2102x1736.
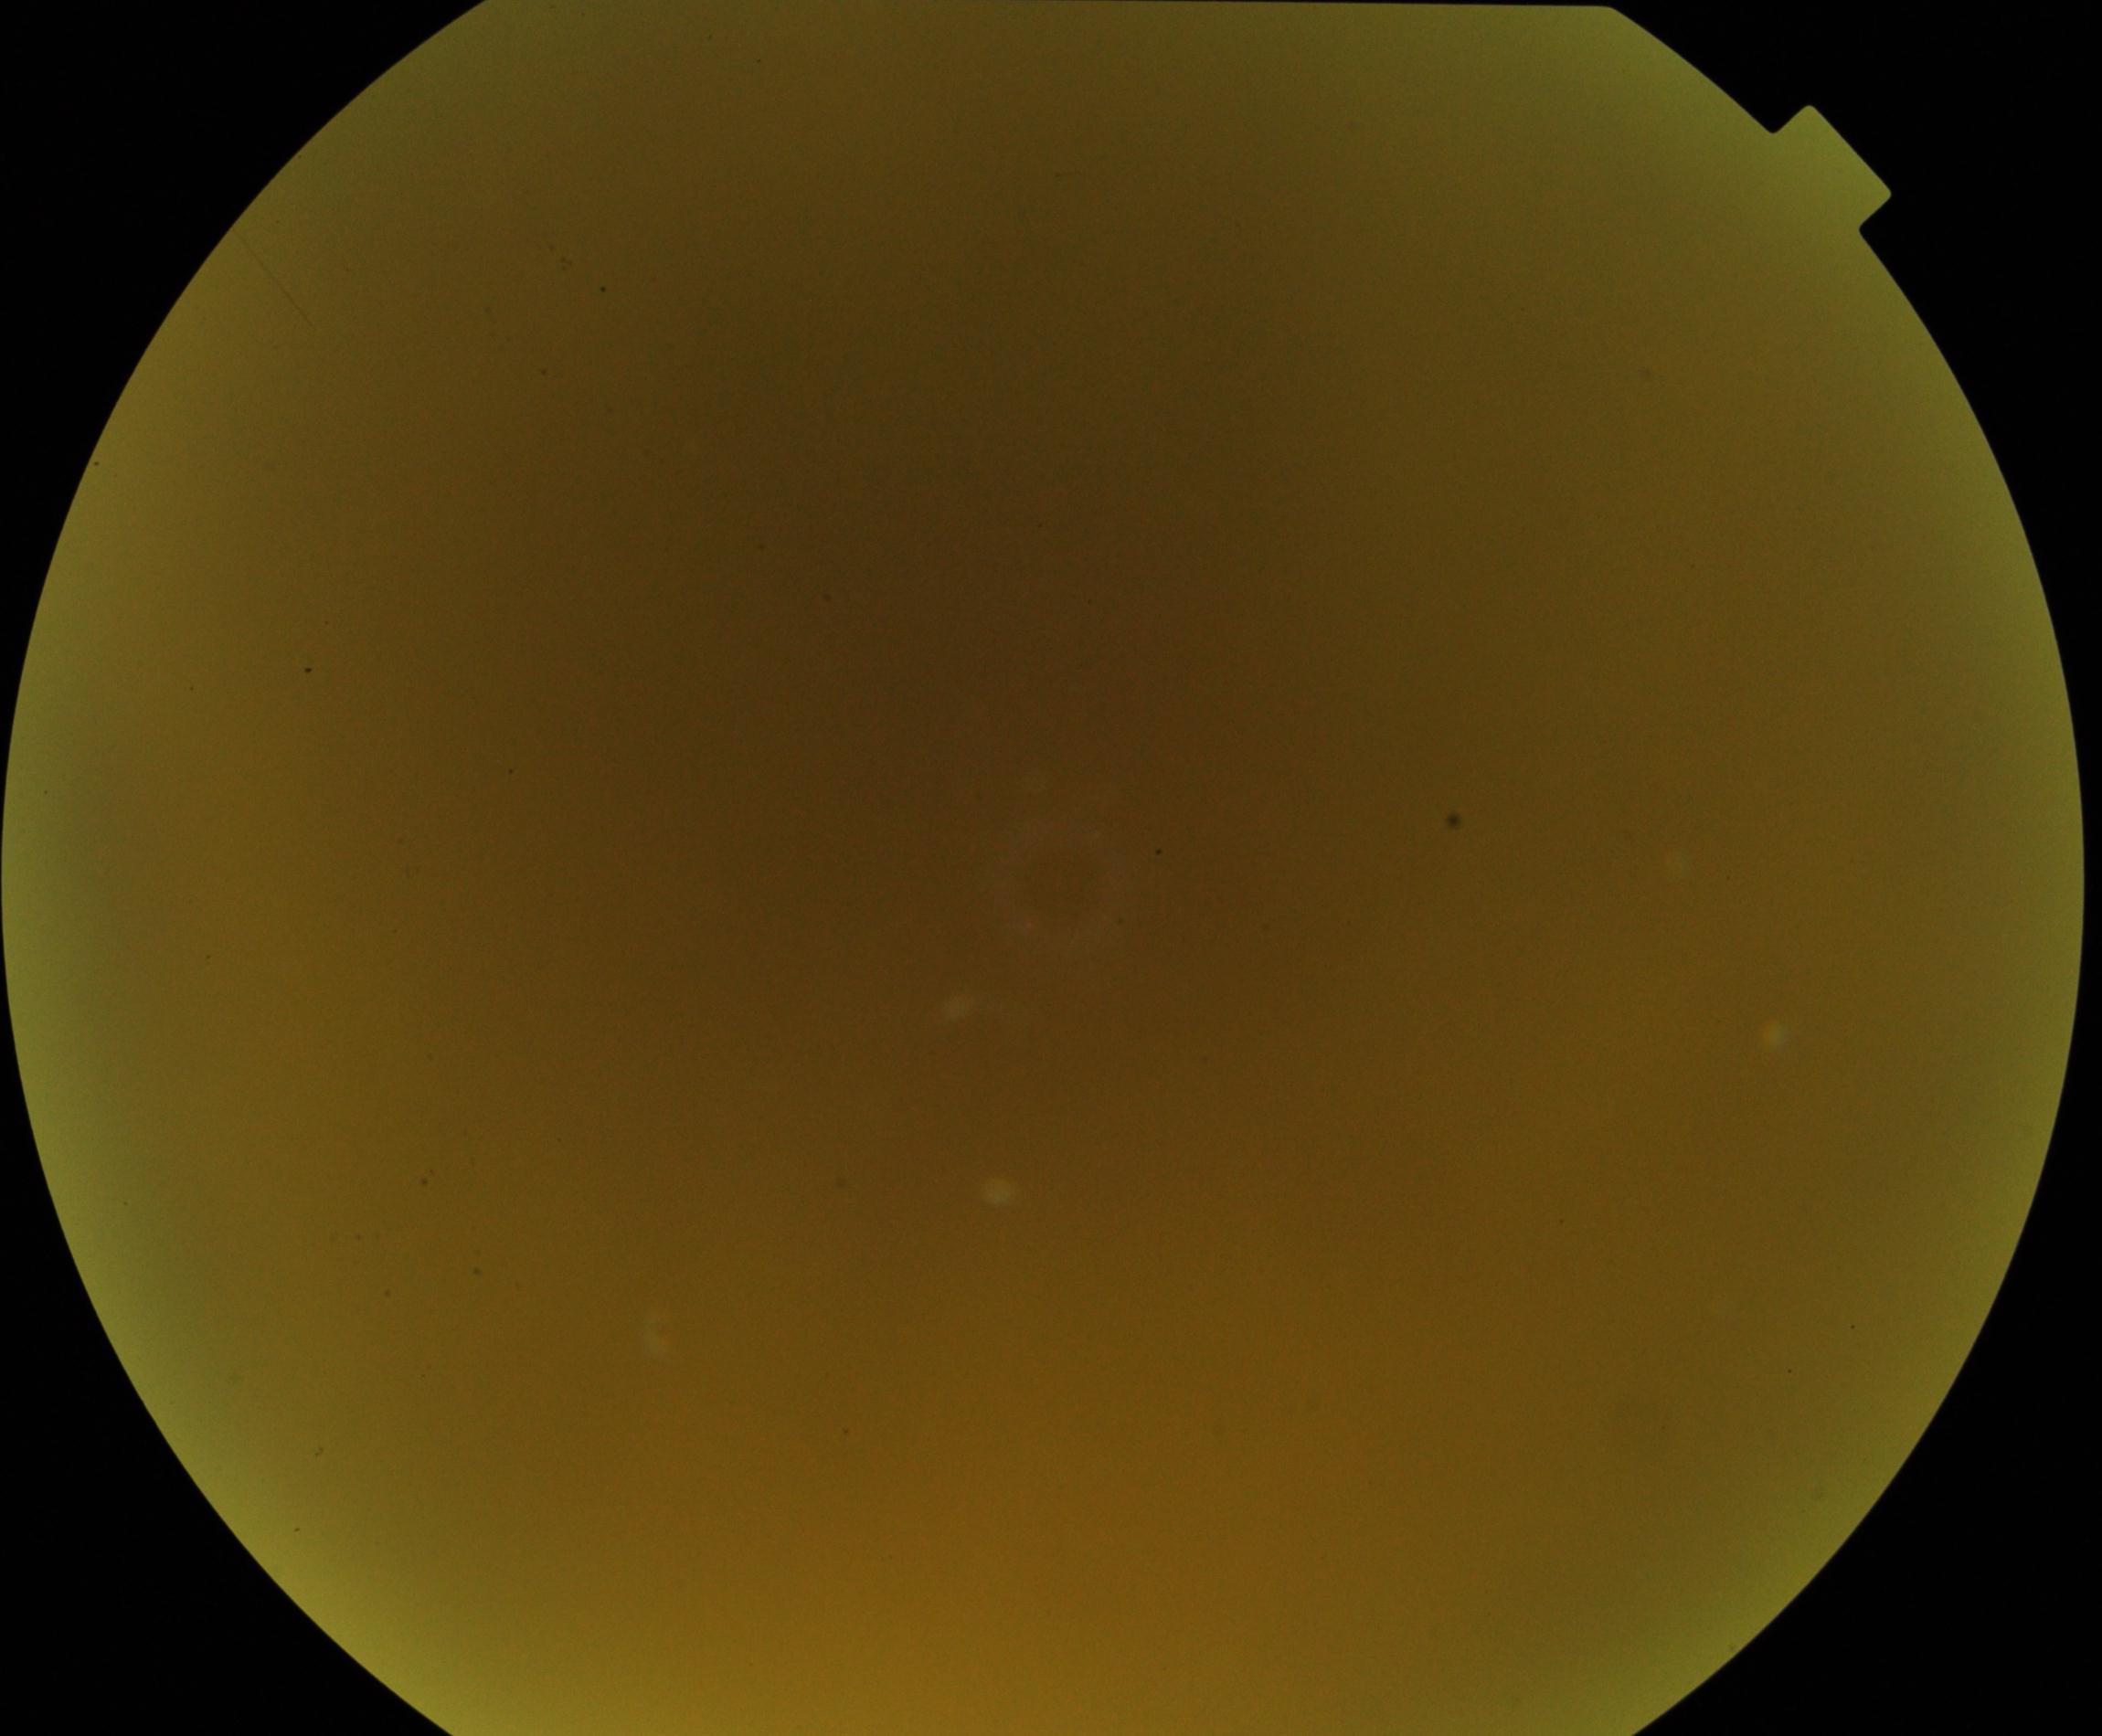
Blurred fundus image with substantial obscuration of retinal landmarks. No evidence of proliferative diabetic retinopathy.